45° field of view
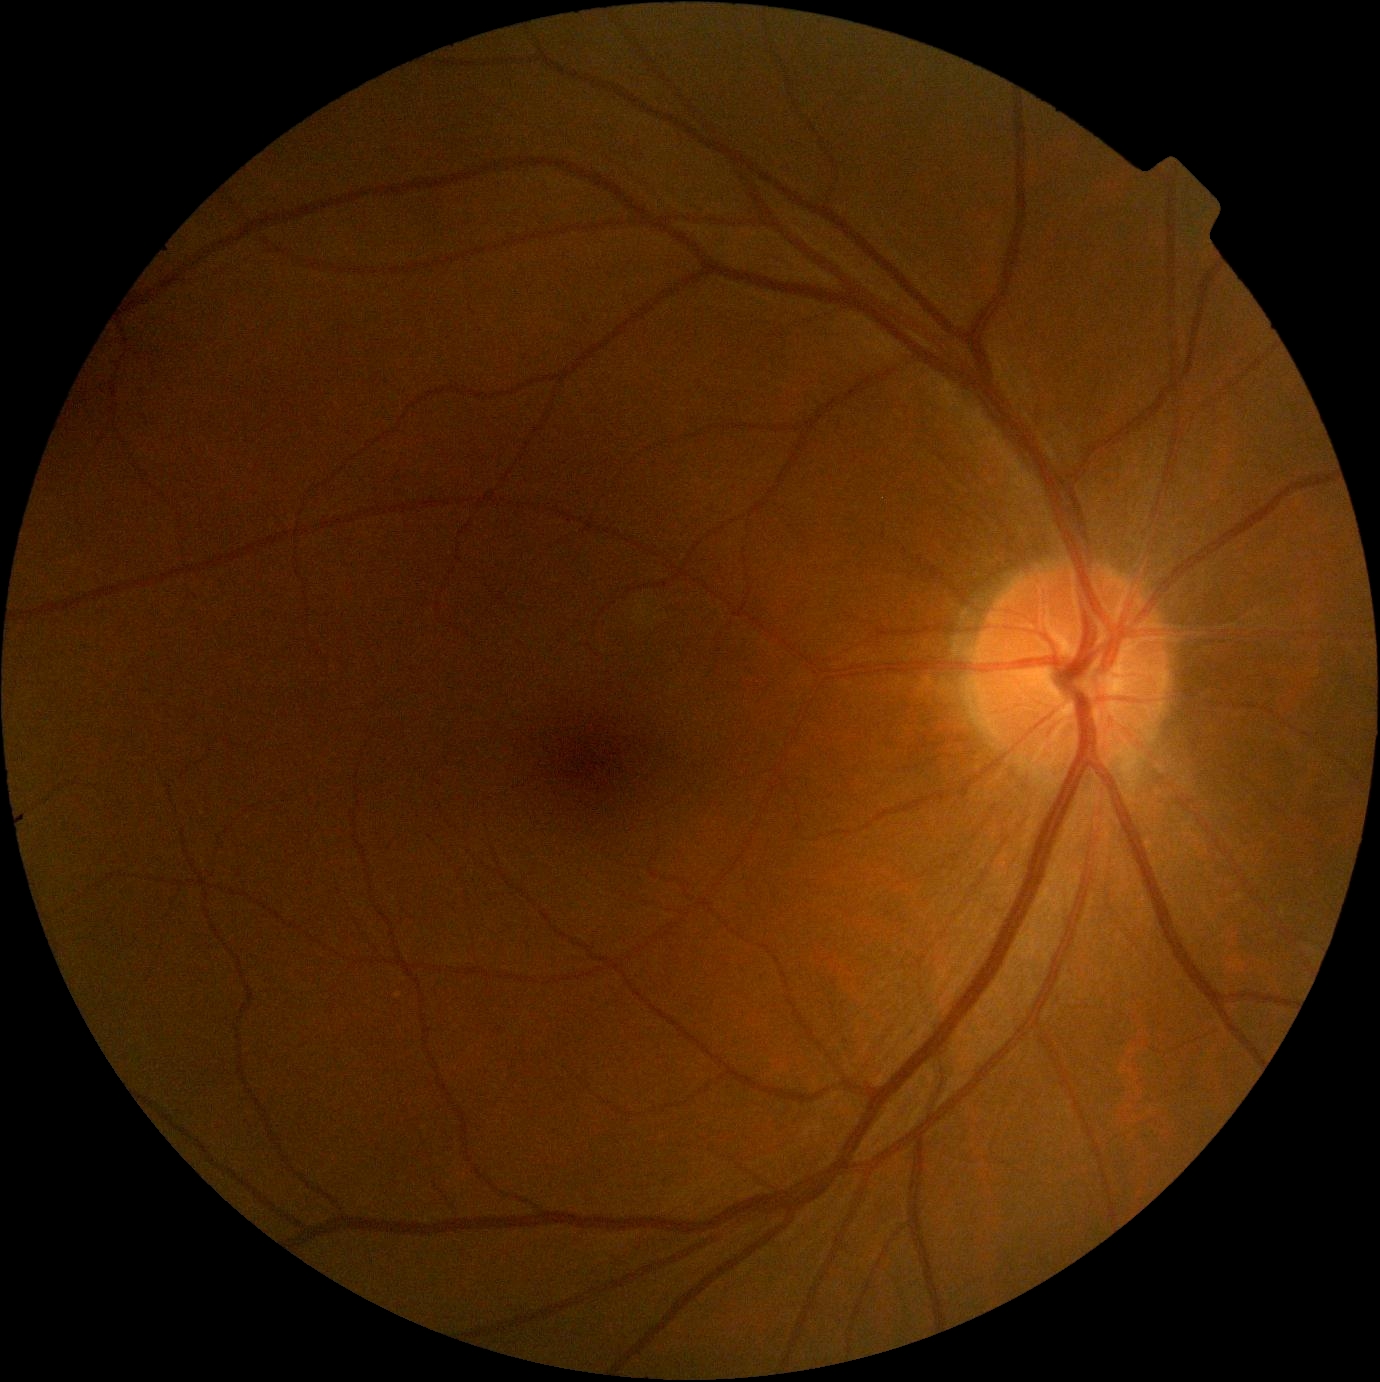

dr_grade: grade 0